NIDEK AFC-230 fundus camera, DR severity per modified Davis staging: 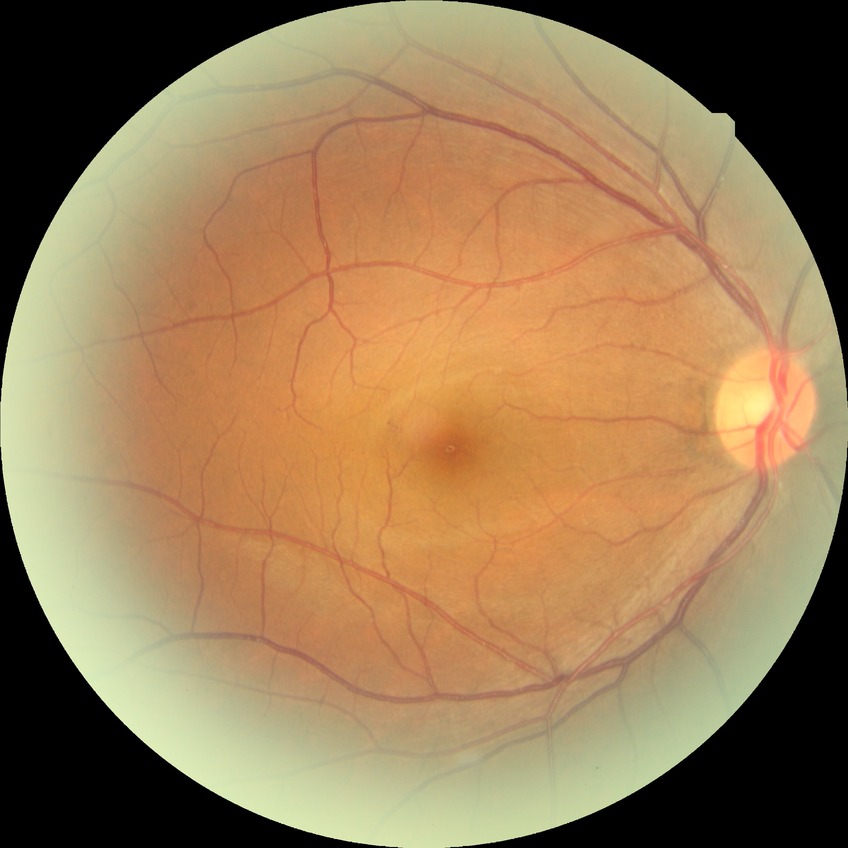
Diabetic retinopathy (DR) is no diabetic retinopathy (NDR).